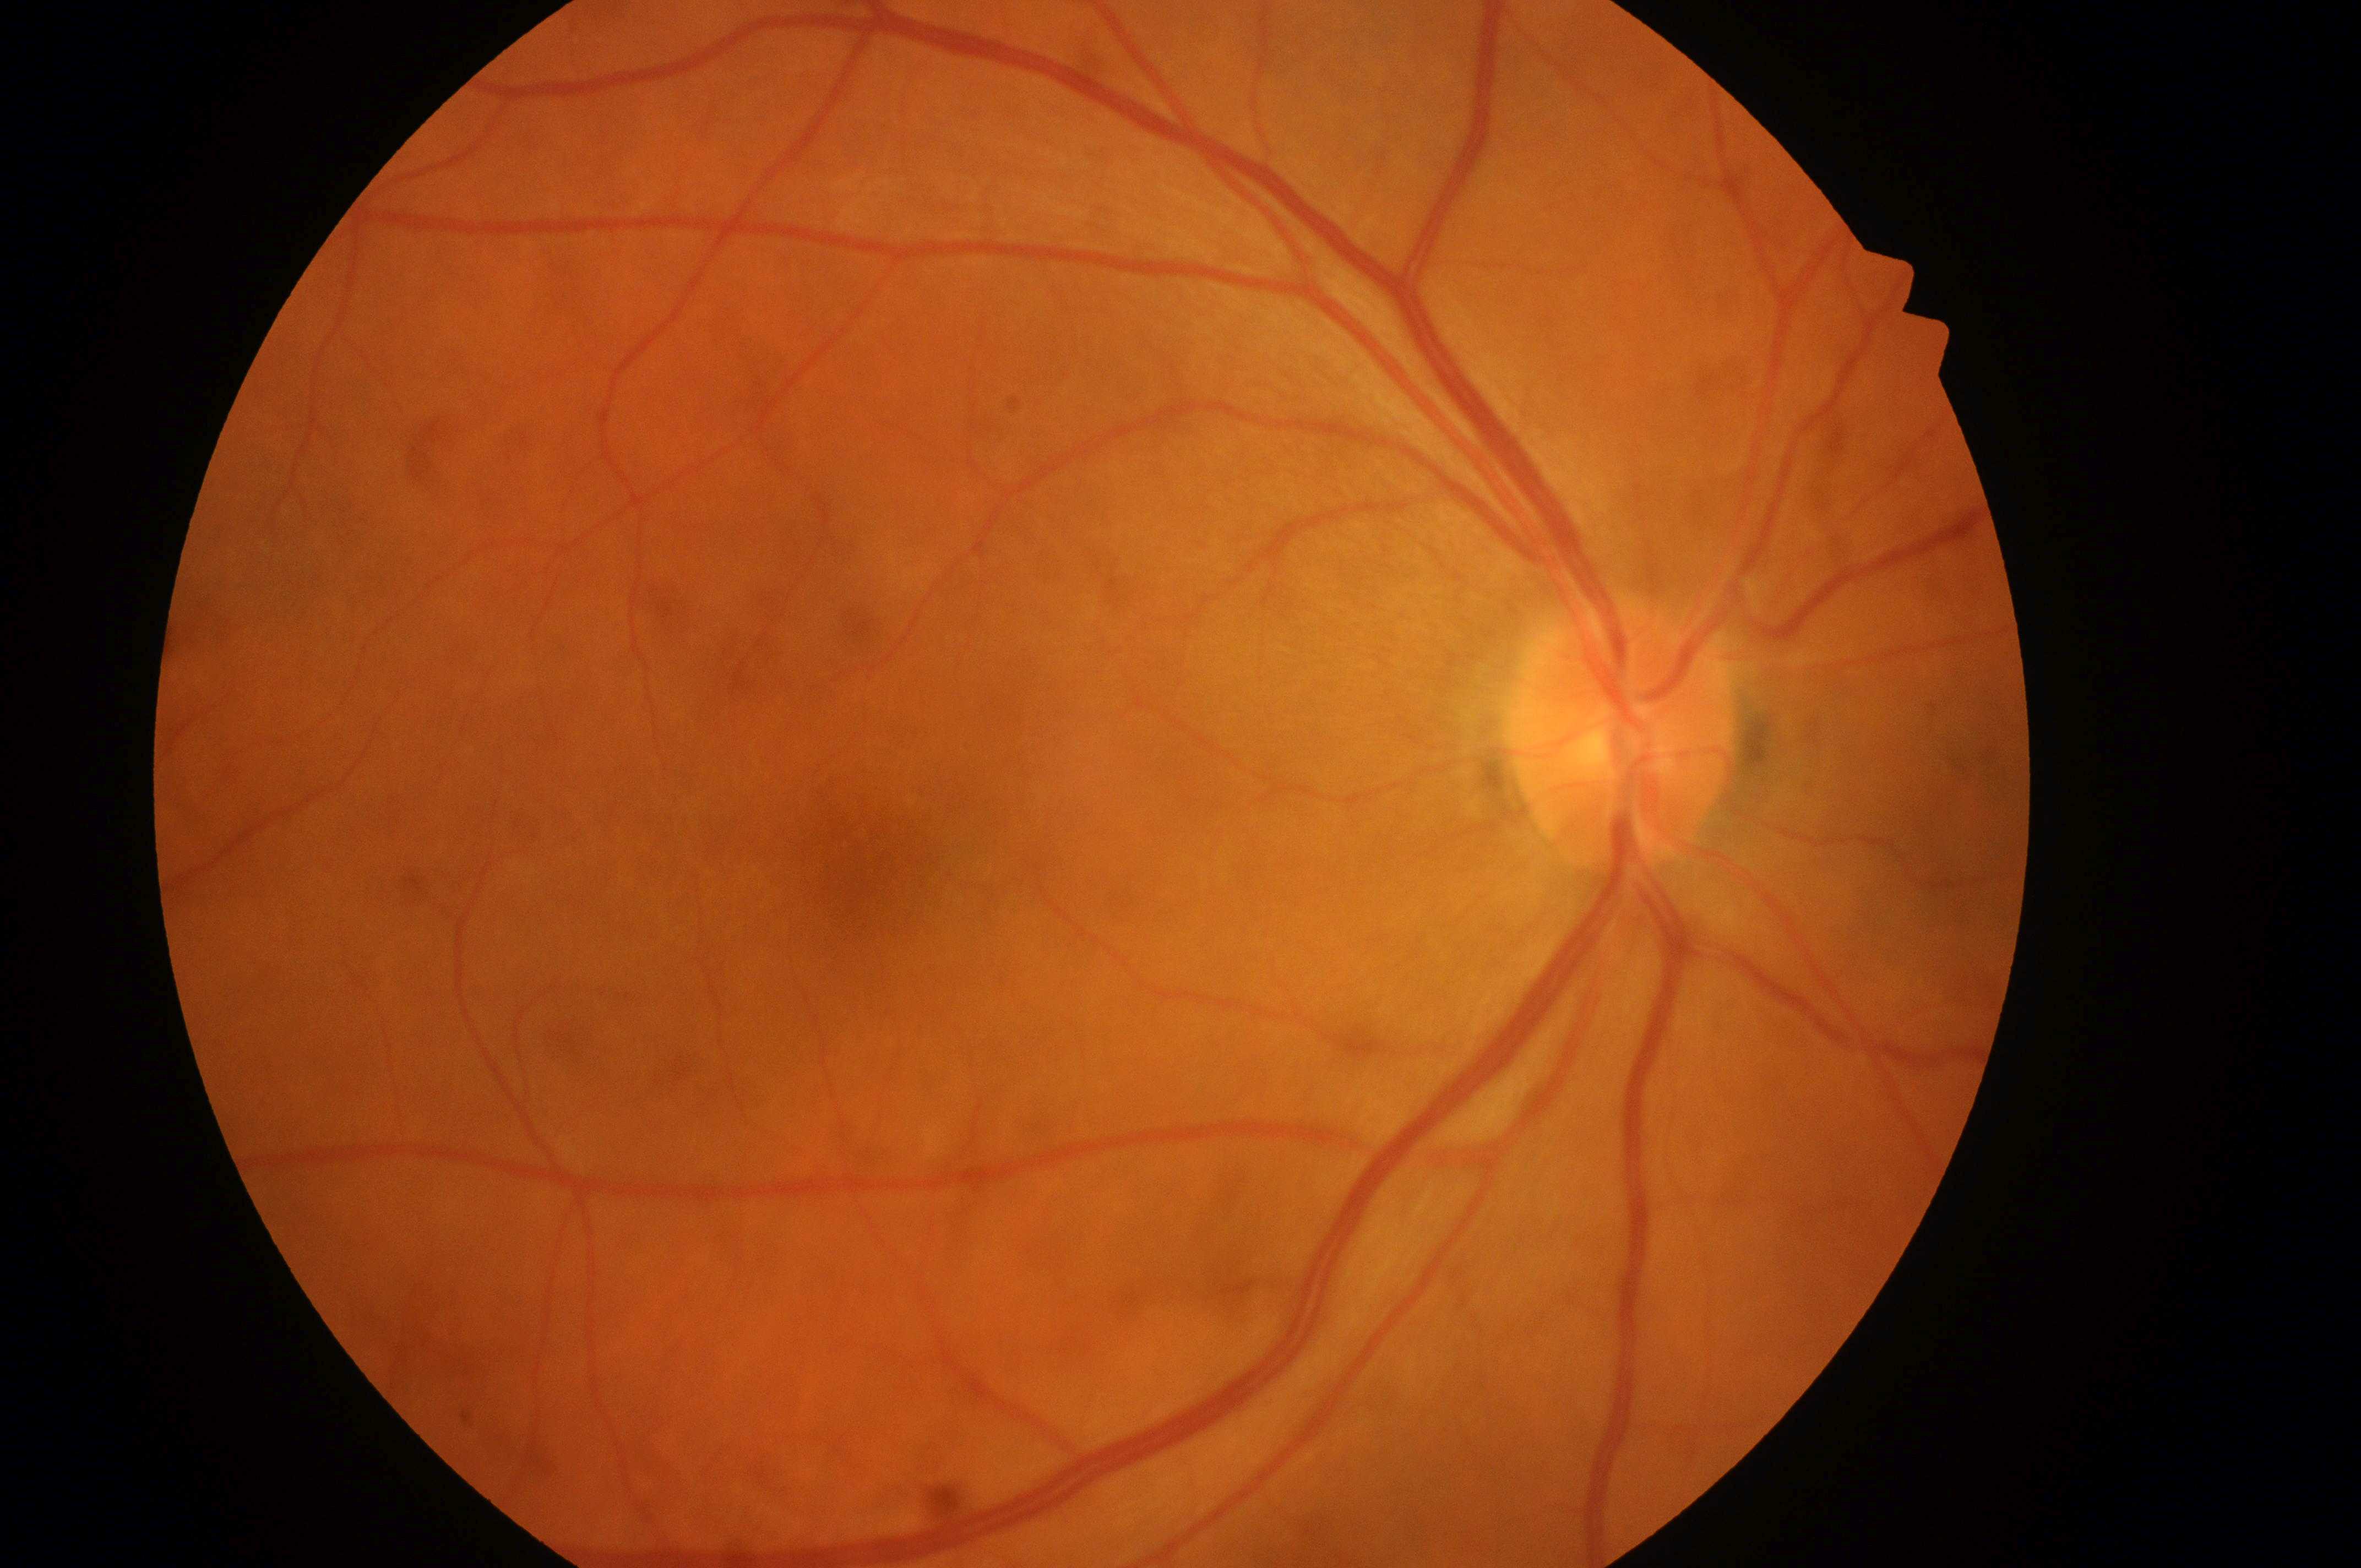
Q: Is there DR or DME?
A: No signs of diabetic retinopathy or diabetic macular edema
Q: Fovea center?
A: x=866, y=858
Q: Which eye is imaged?
A: OD
Q: DME grade?
A: grade 0 — no apparent hard exudates
Q: Locate the optic disc.
A: x=1617, y=748
Q: What is the DR grade?
A: 0/4 — no visible signs of diabetic retinopathy